848 by 848 pixels; without pupil dilation:
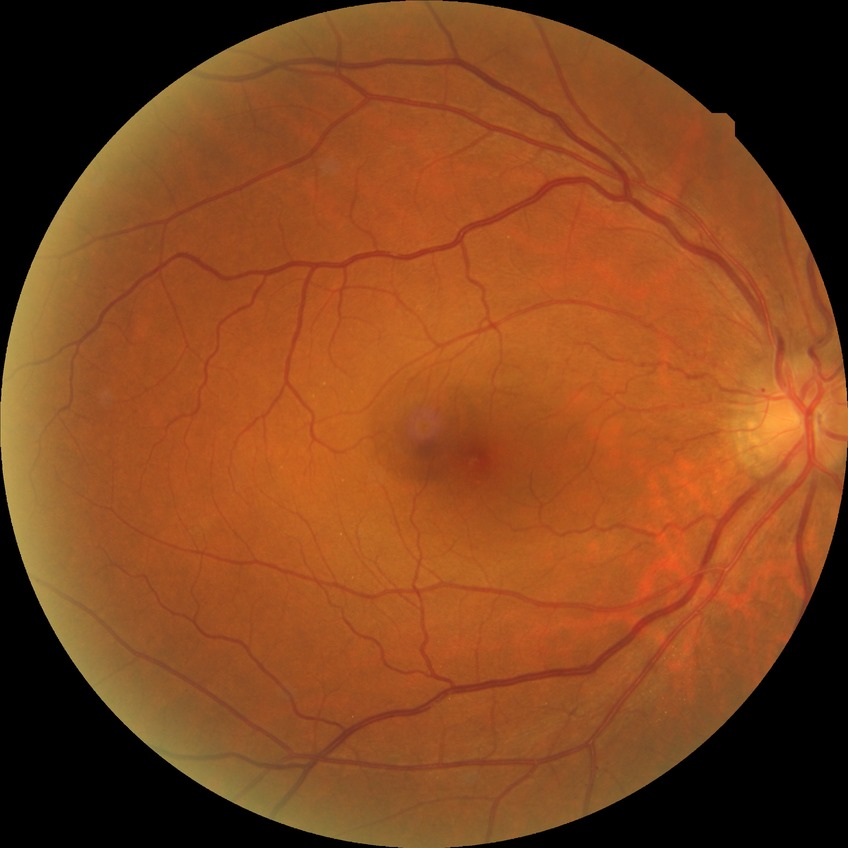
davis_grade: SDR (simple diabetic retinopathy)
proliferative_class: non-proliferative diabetic retinopathy